Acquired on the Clarity RetCam 3 · wide-field fundus photograph of an infant · 640 by 480 pixels: 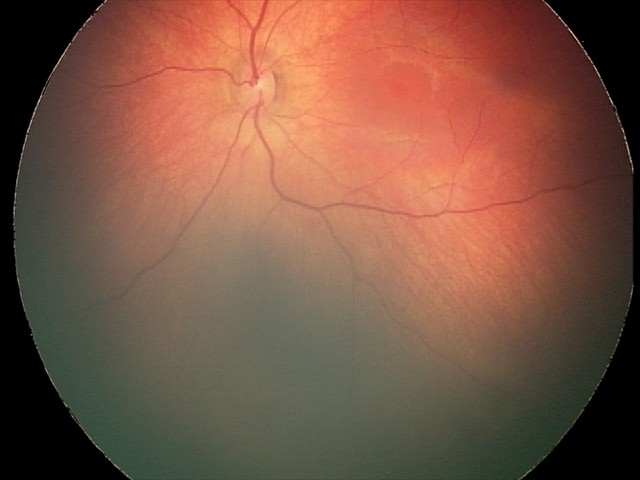 Q: What is the diagnosis from this examination?
A: retinal hemorrhages